Wide-field fundus photograph of an infant — 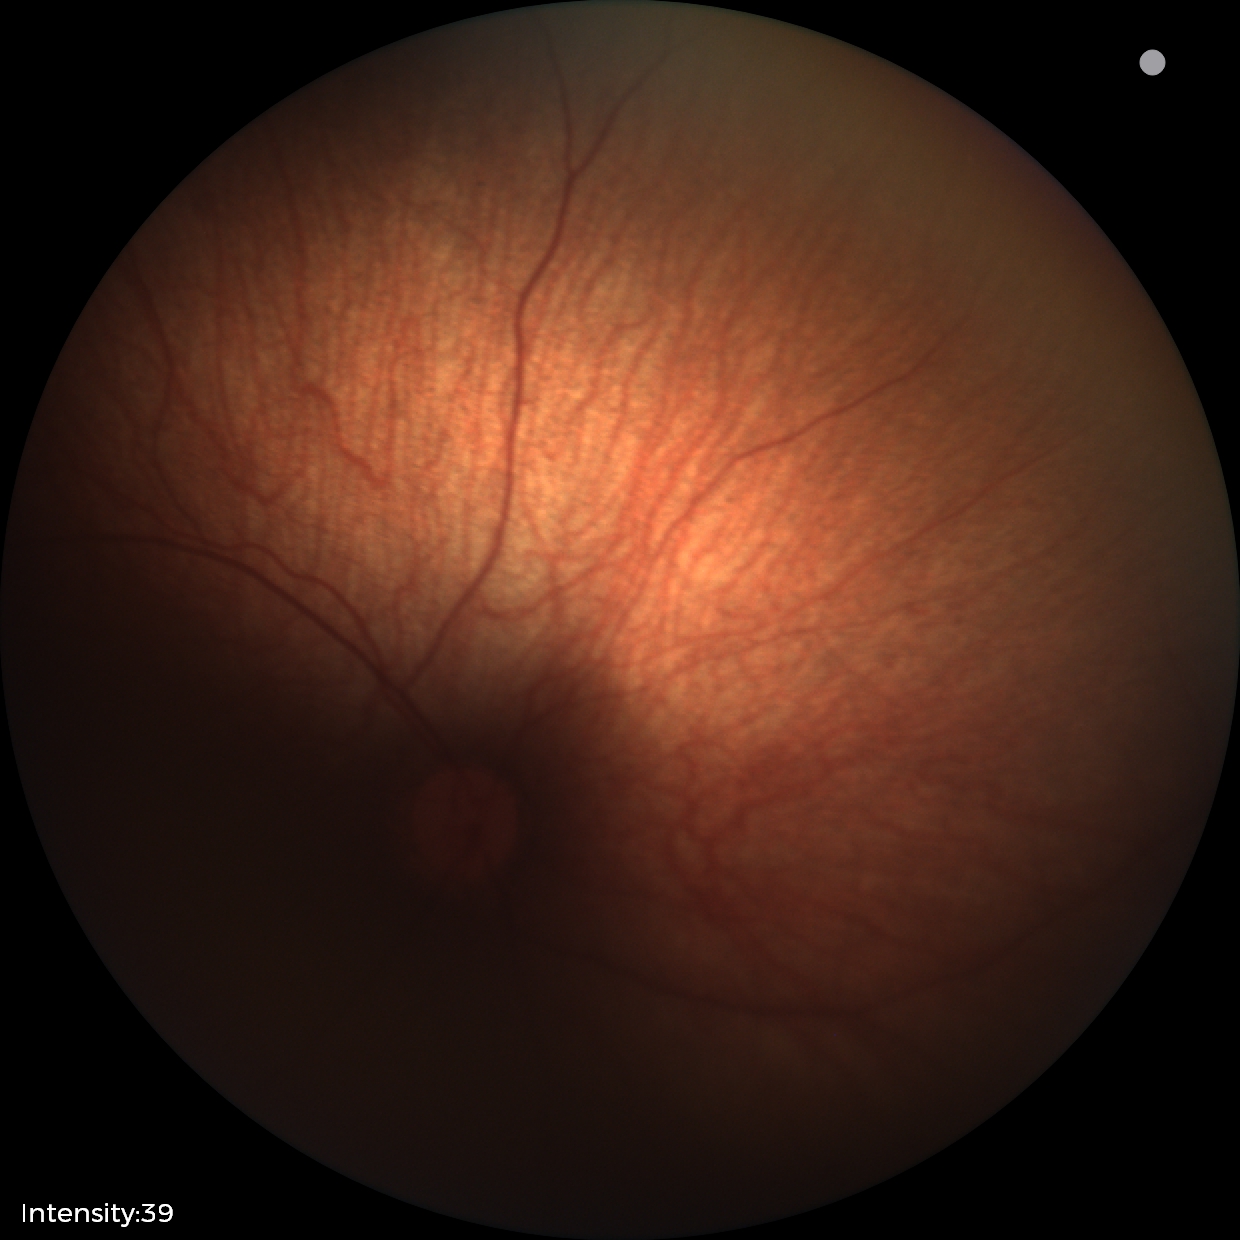
No retinal pathology identified on screening.